FOV: 45 degrees.
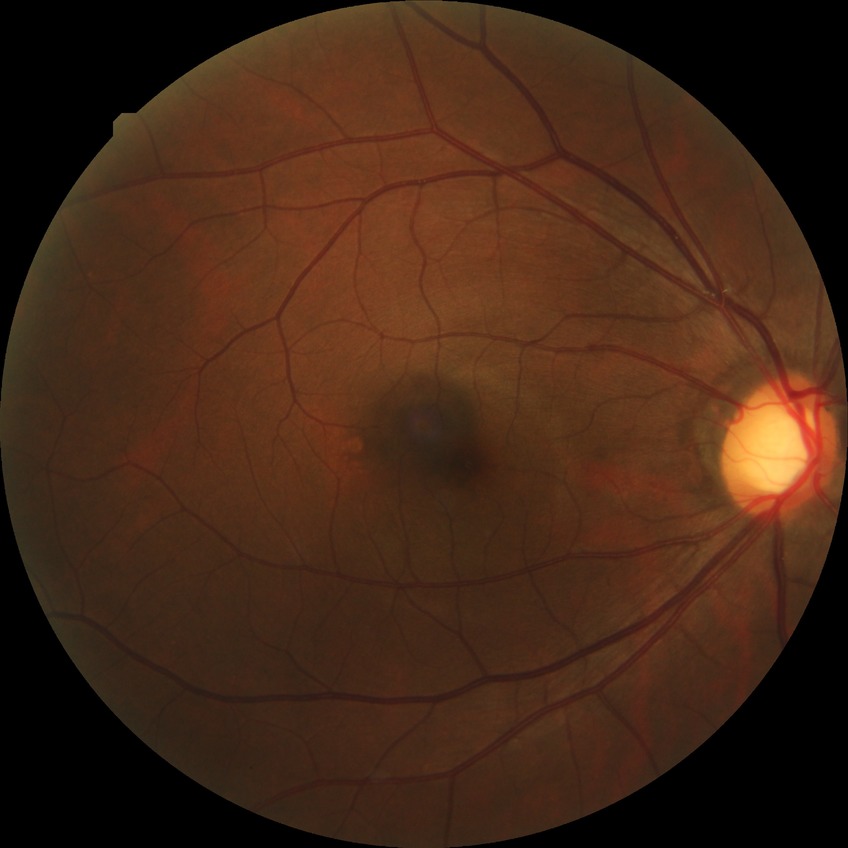

Annotations:
- diabetic retinopathy (DR) — no diabetic retinopathy (NDR)